Nidek AFC-330
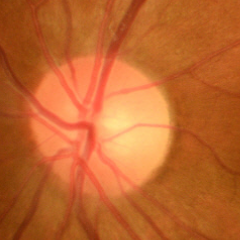
No glaucoma.